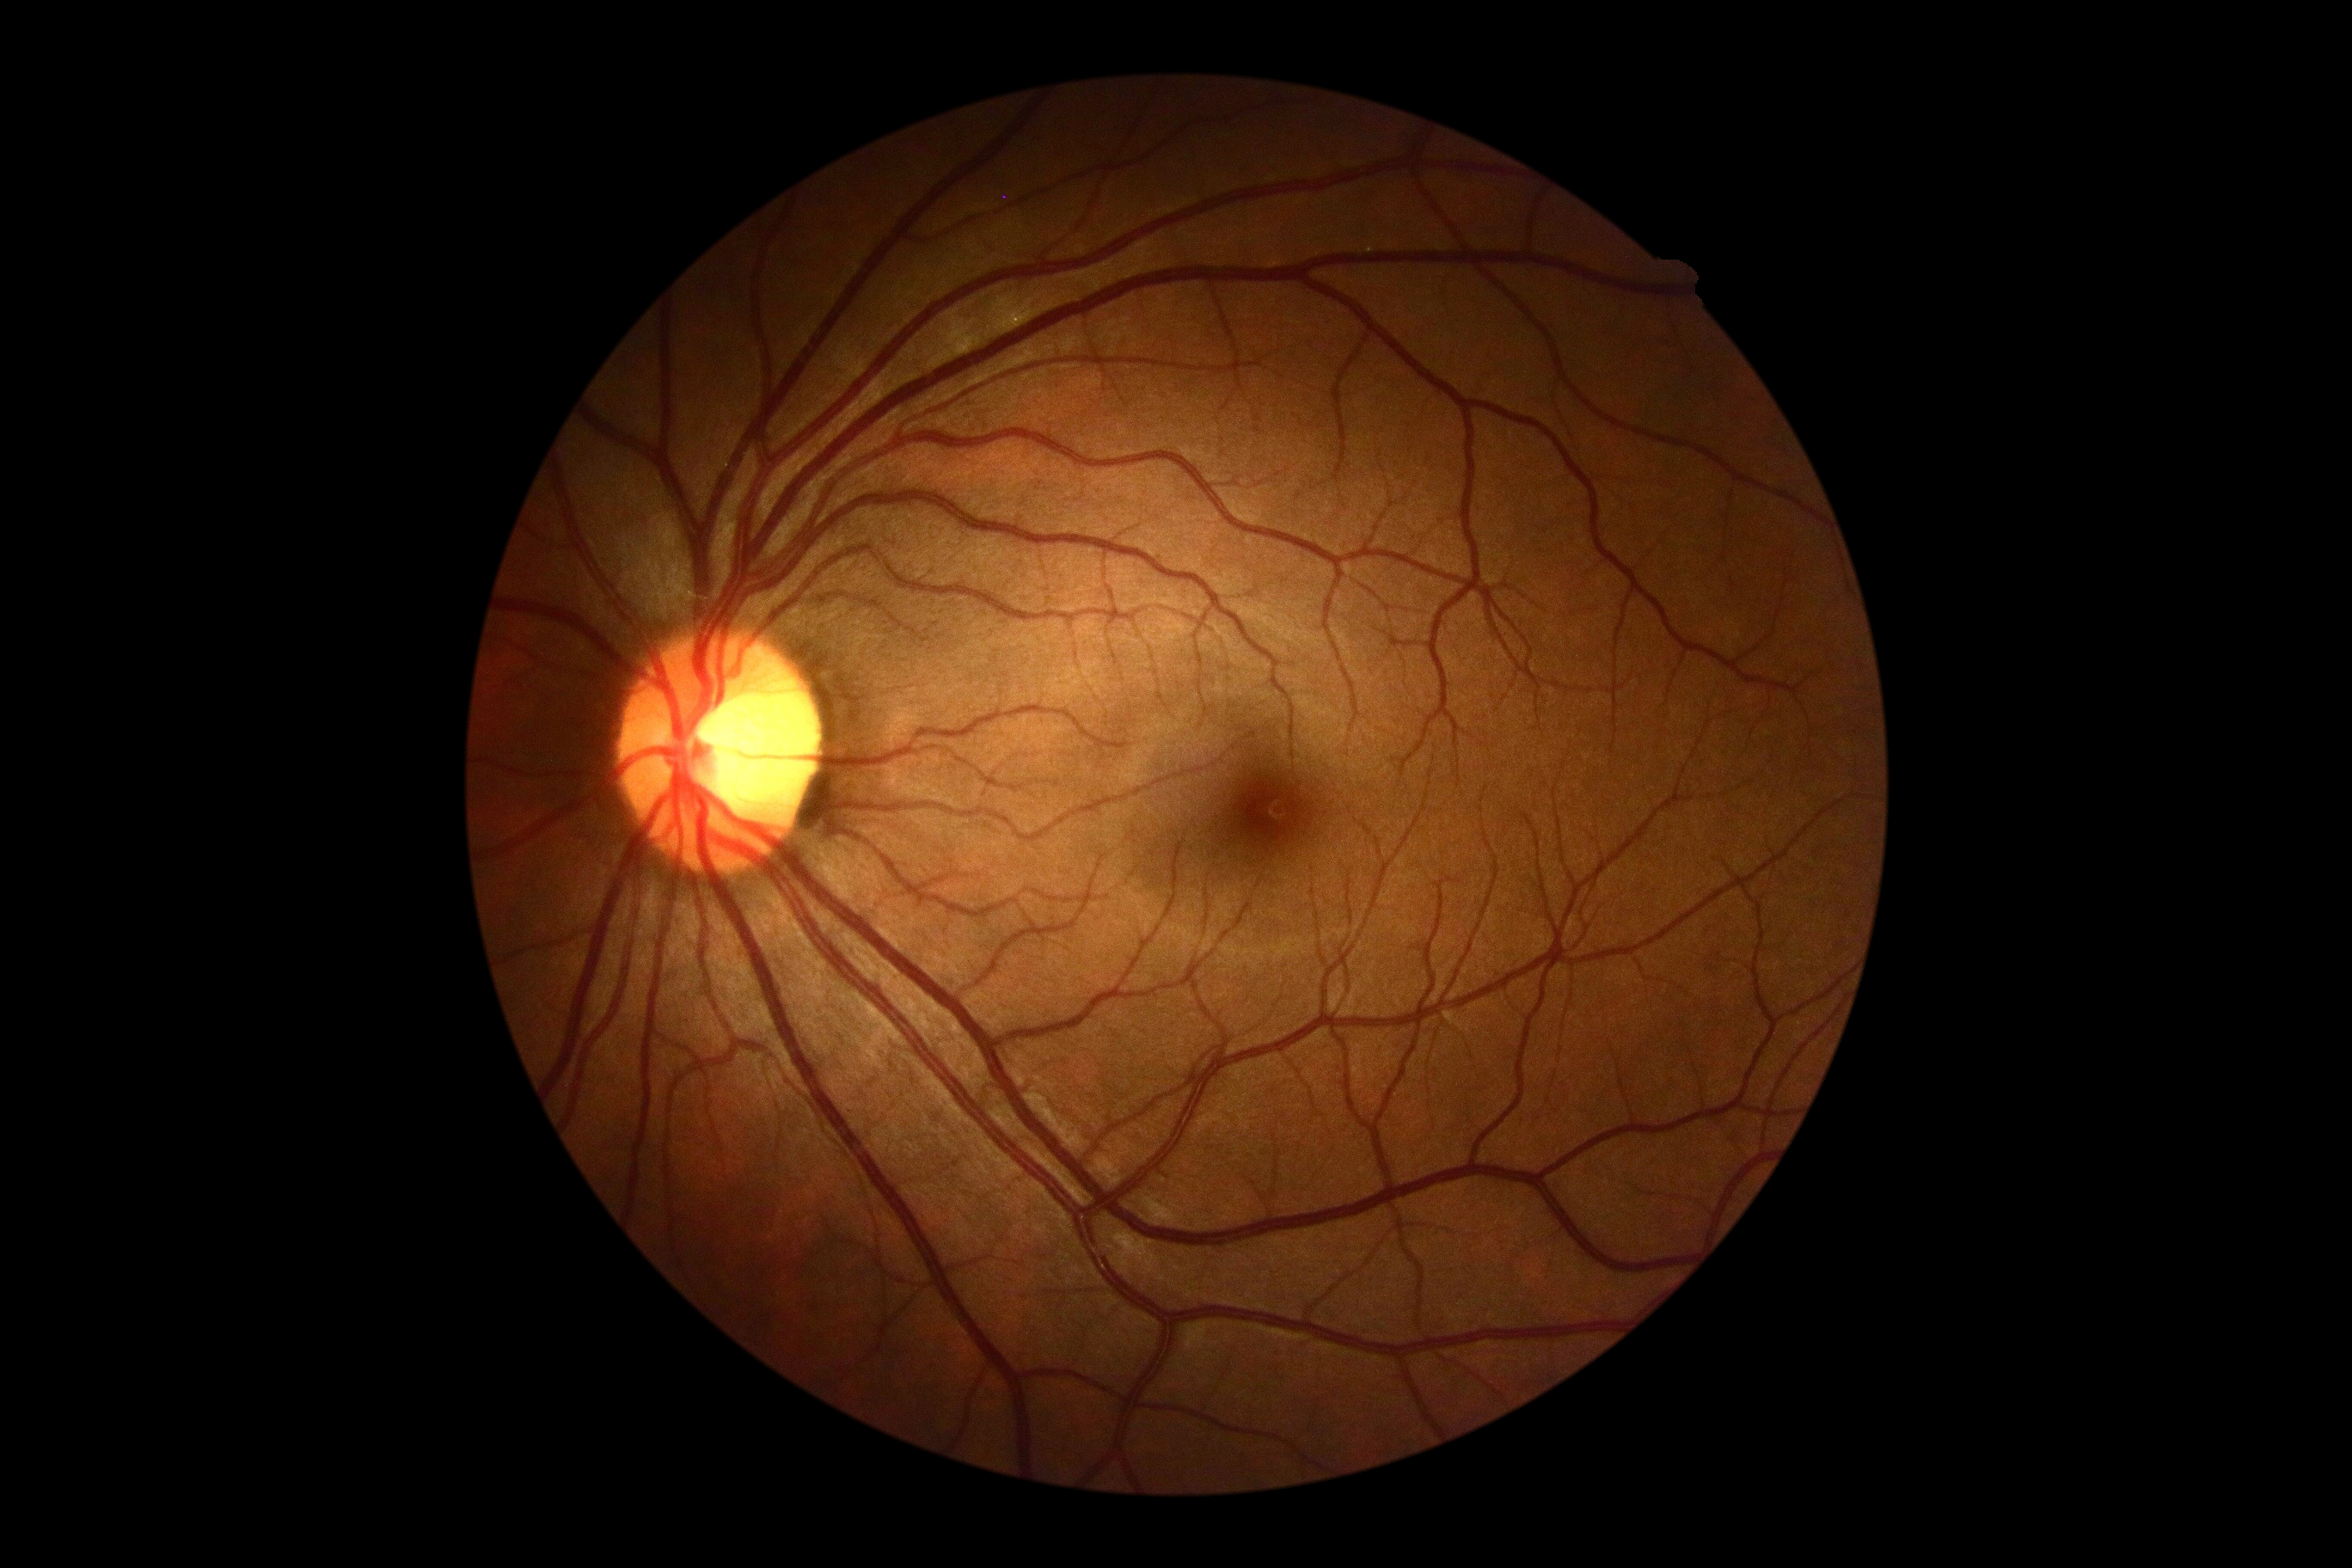 DR: grade 0, DR impression: no signs of DR.